Color fundus image; 45-degree field of view: 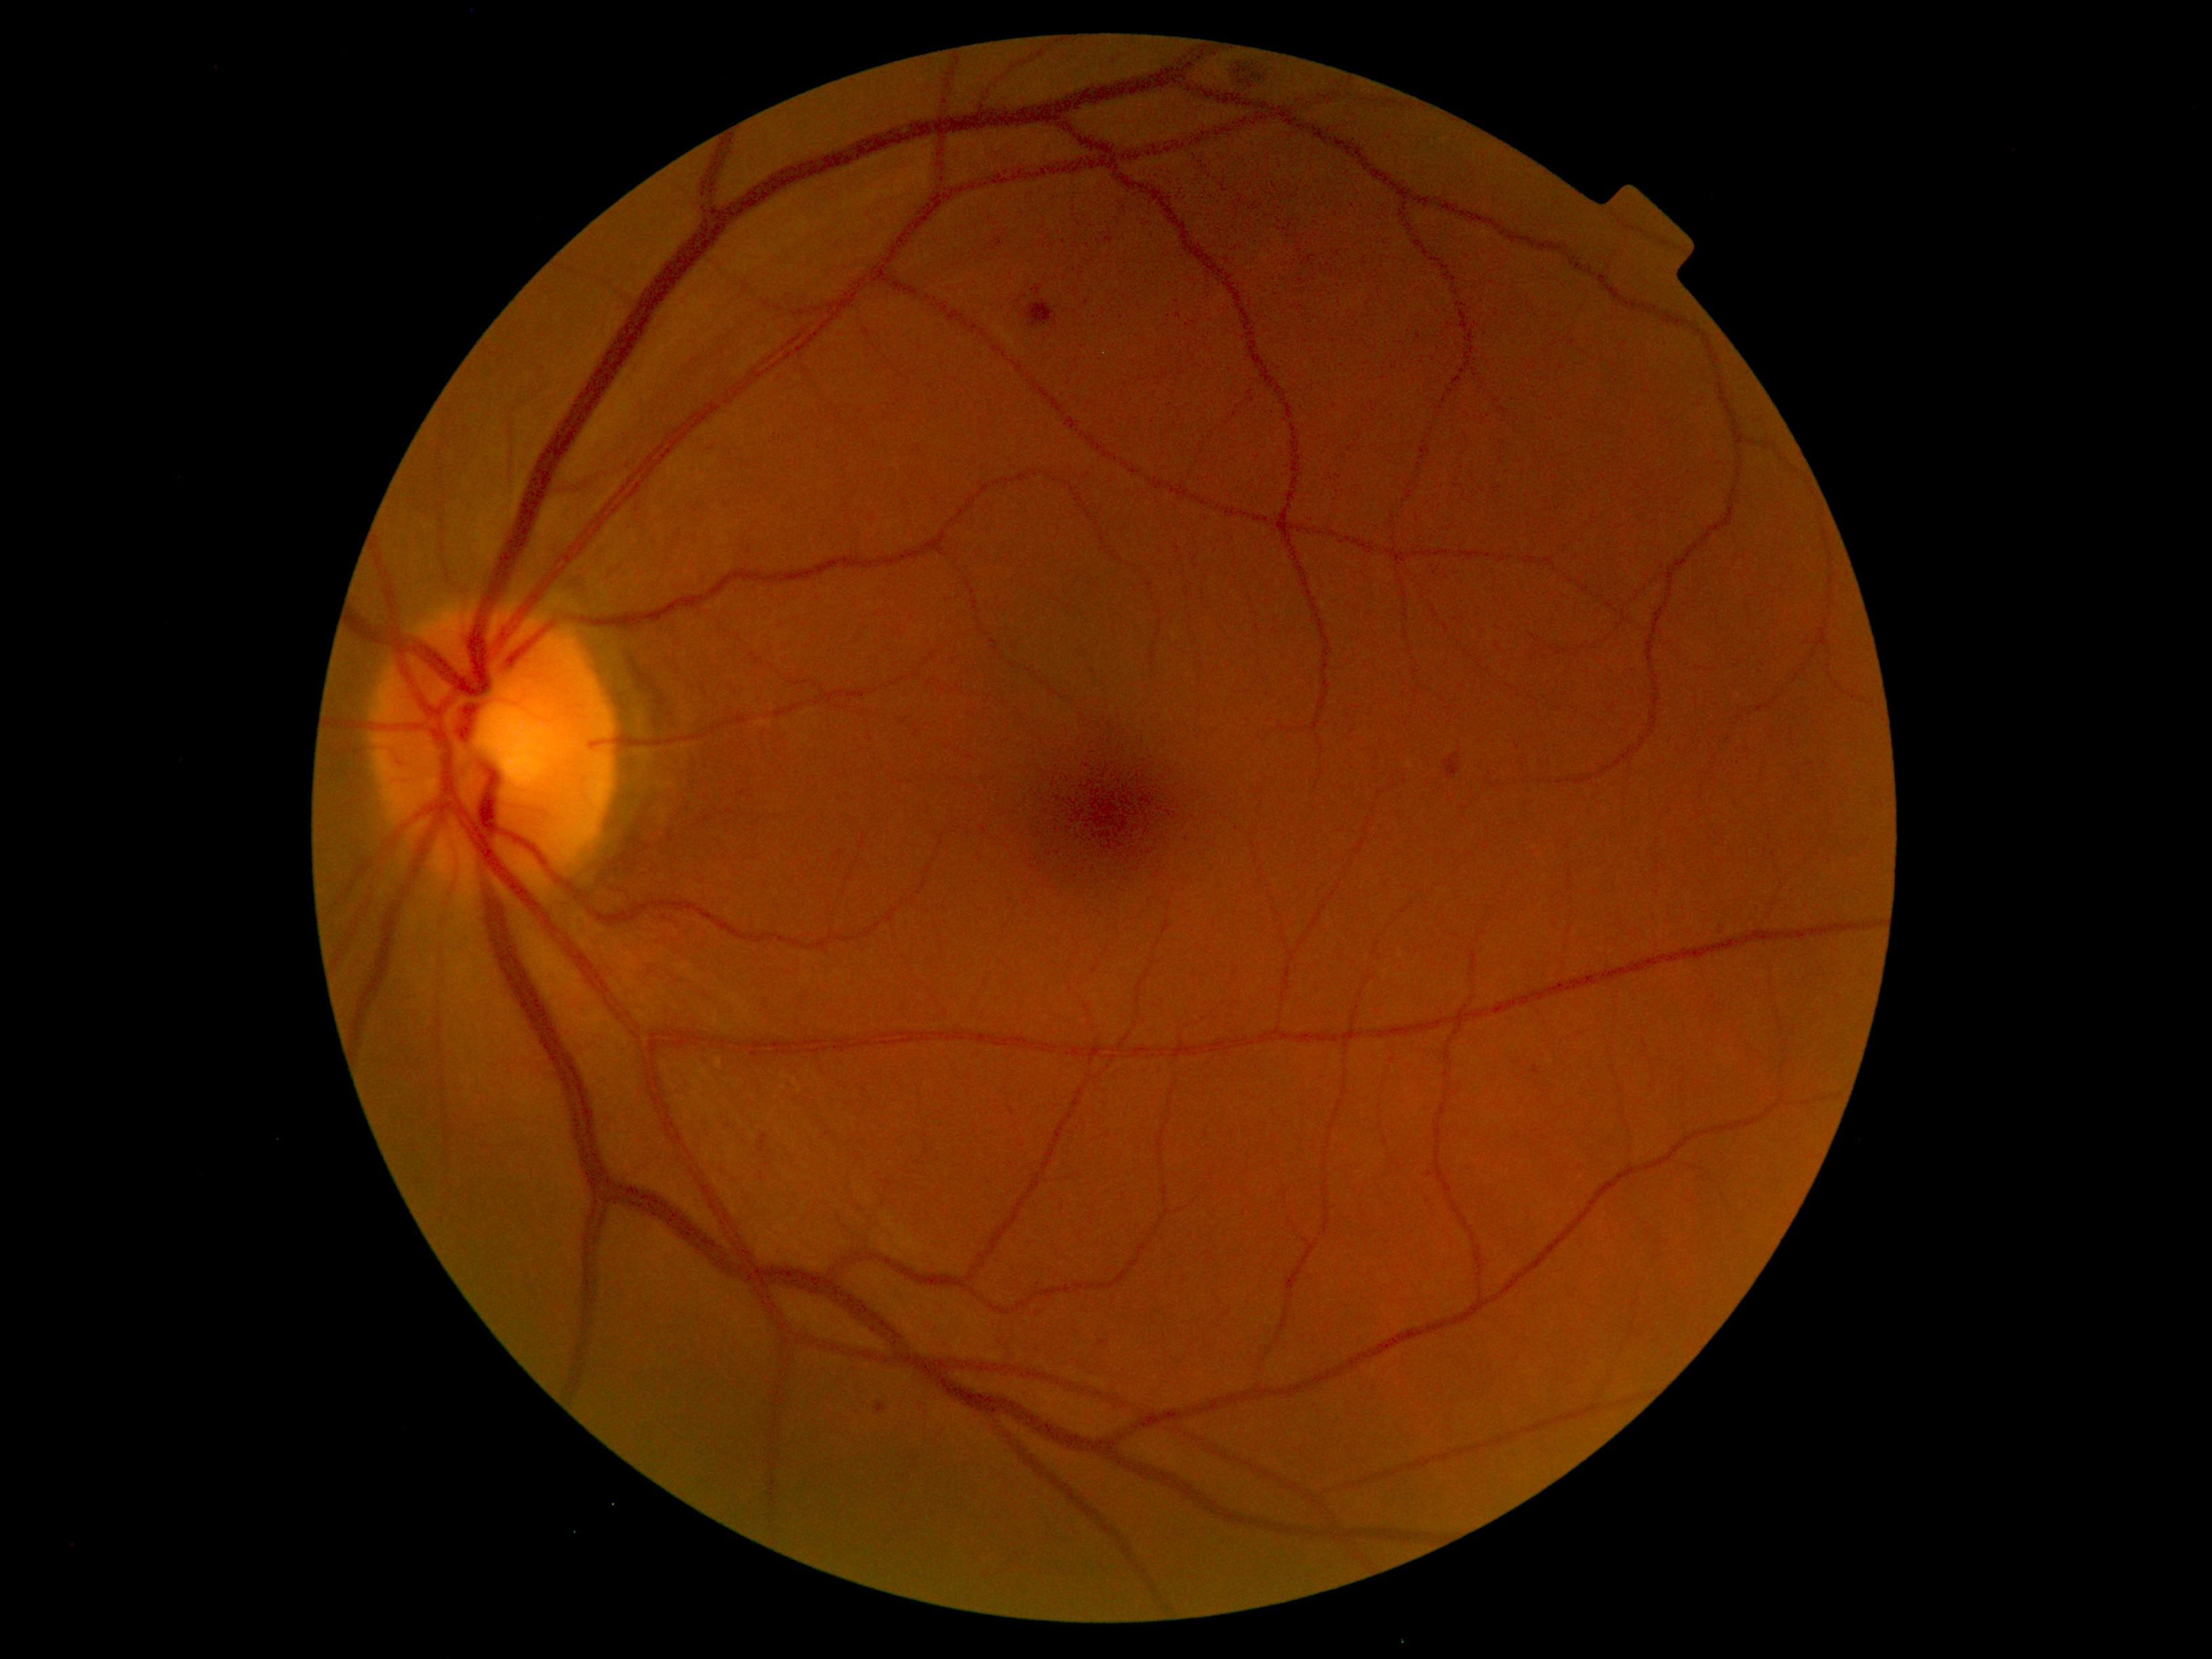
DR stage: grade 2 (moderate NPDR). DR class: non-proliferative diabetic retinopathy.